Image size 2048x1536 — 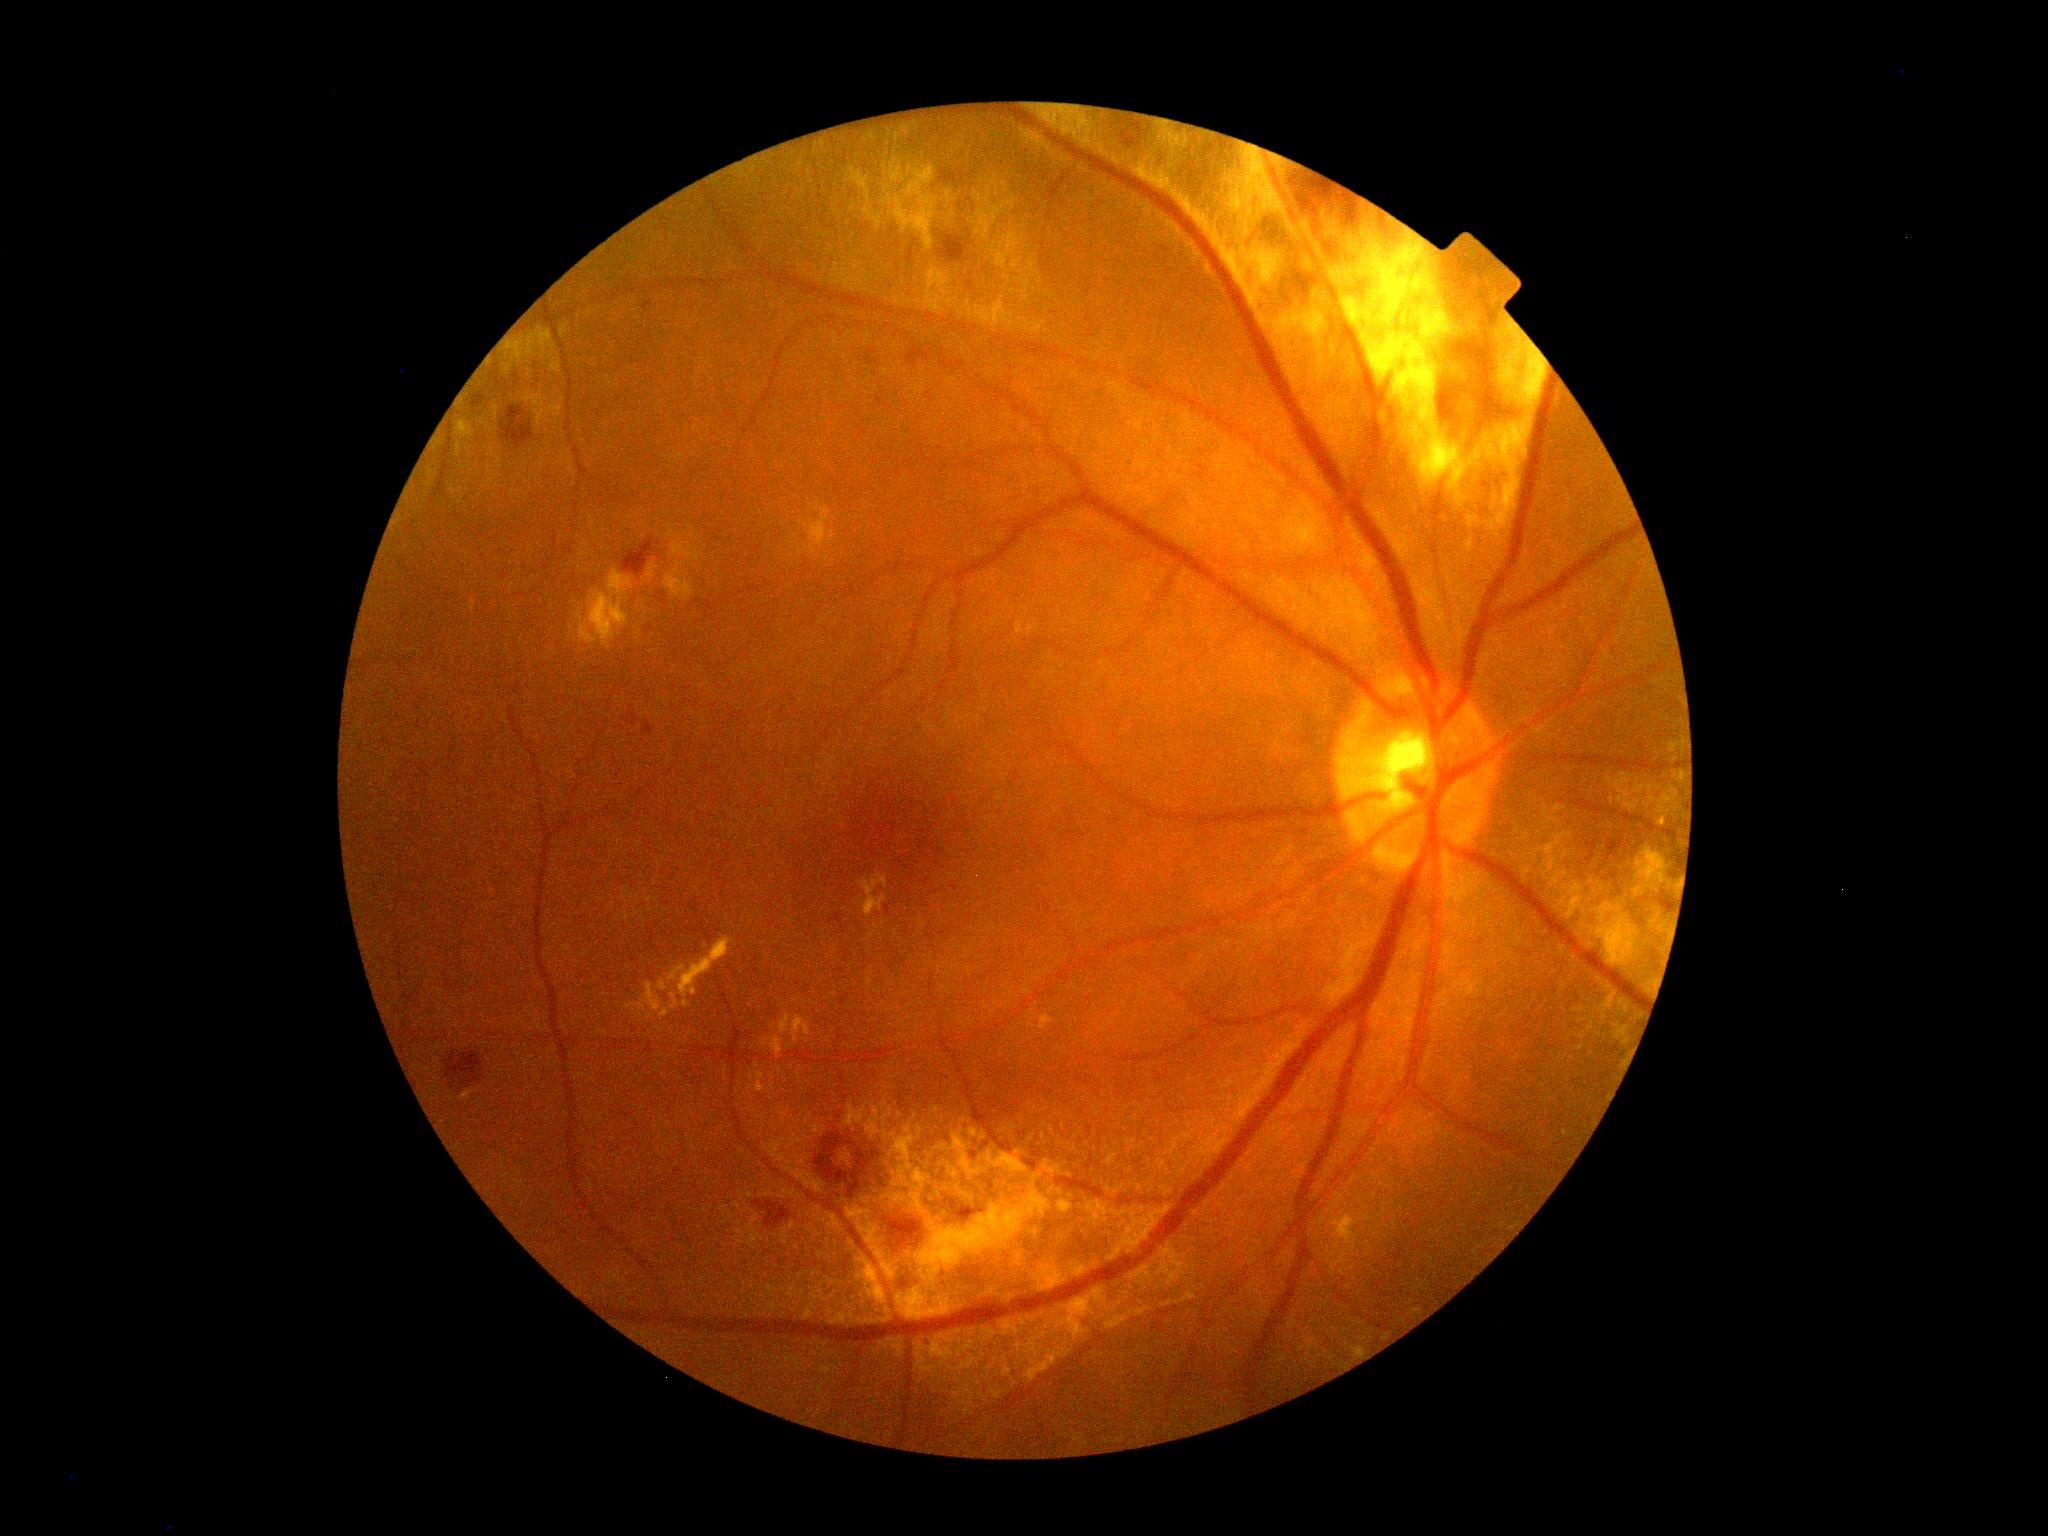 Diabetic retinopathy is 2/4.